Pediatric wide-field fundus photograph. 1440x1080
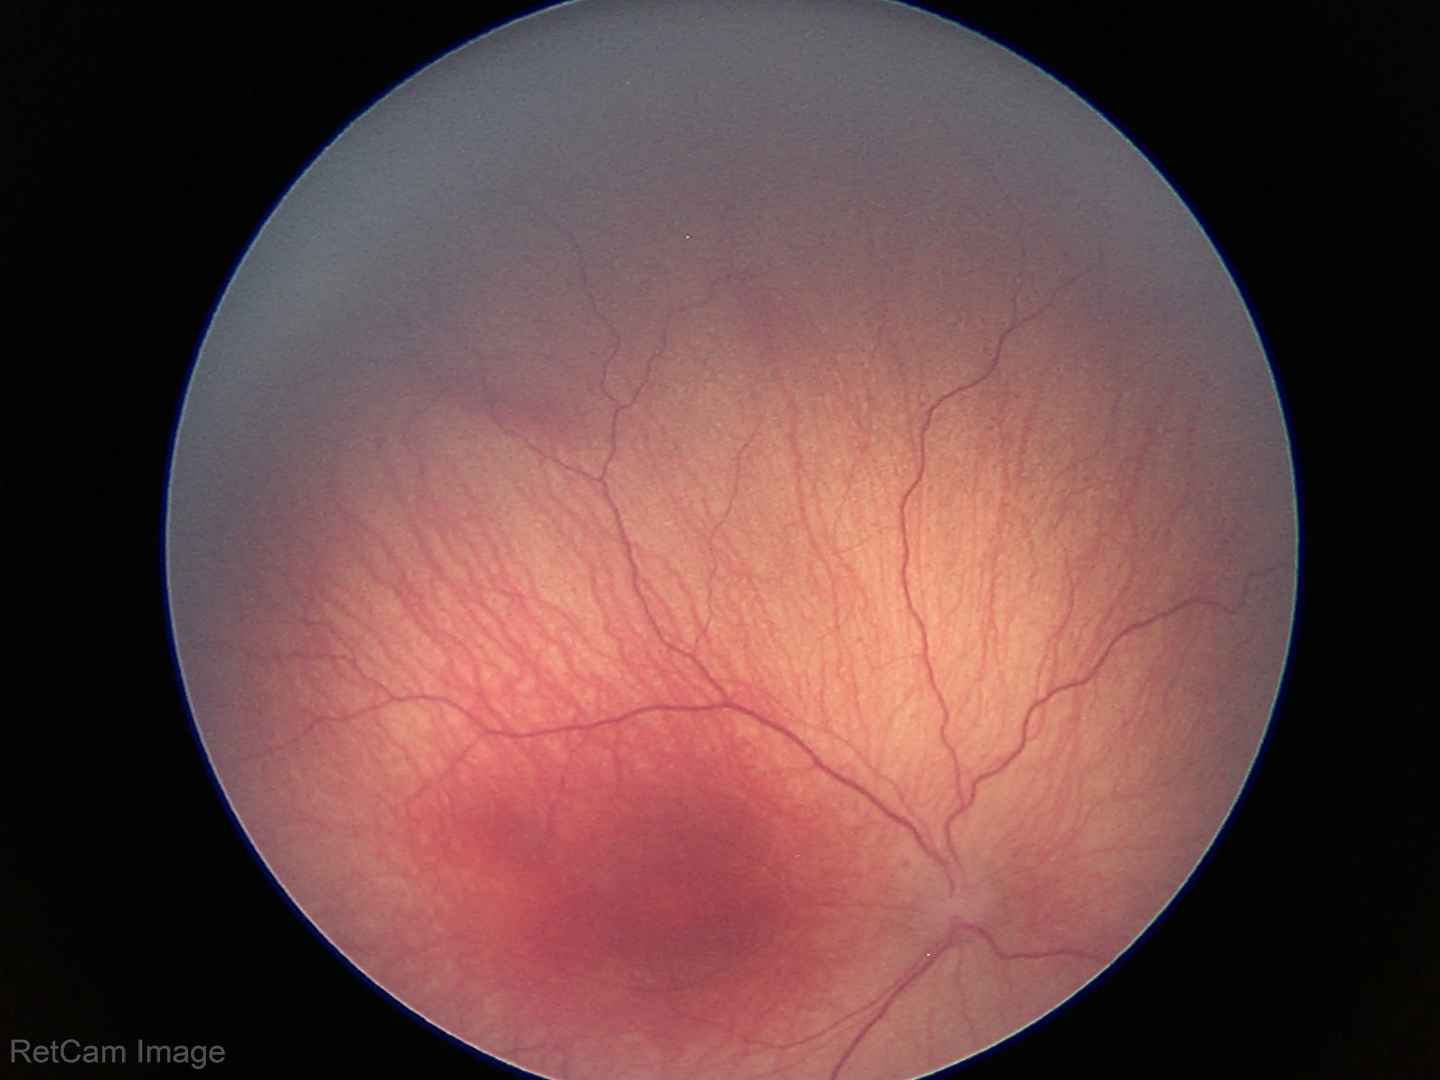 Screening examination consistent with retinopathy of prematurity (ROP) stage 1.